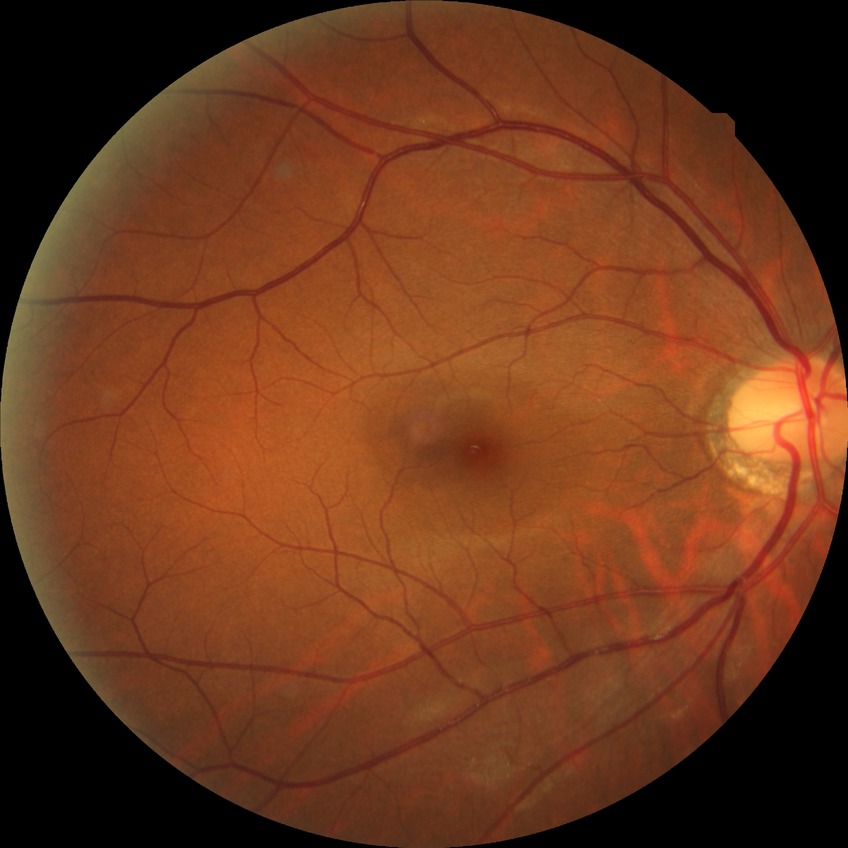
Diabetic retinopathy (DR) is no diabetic retinopathy (NDR).